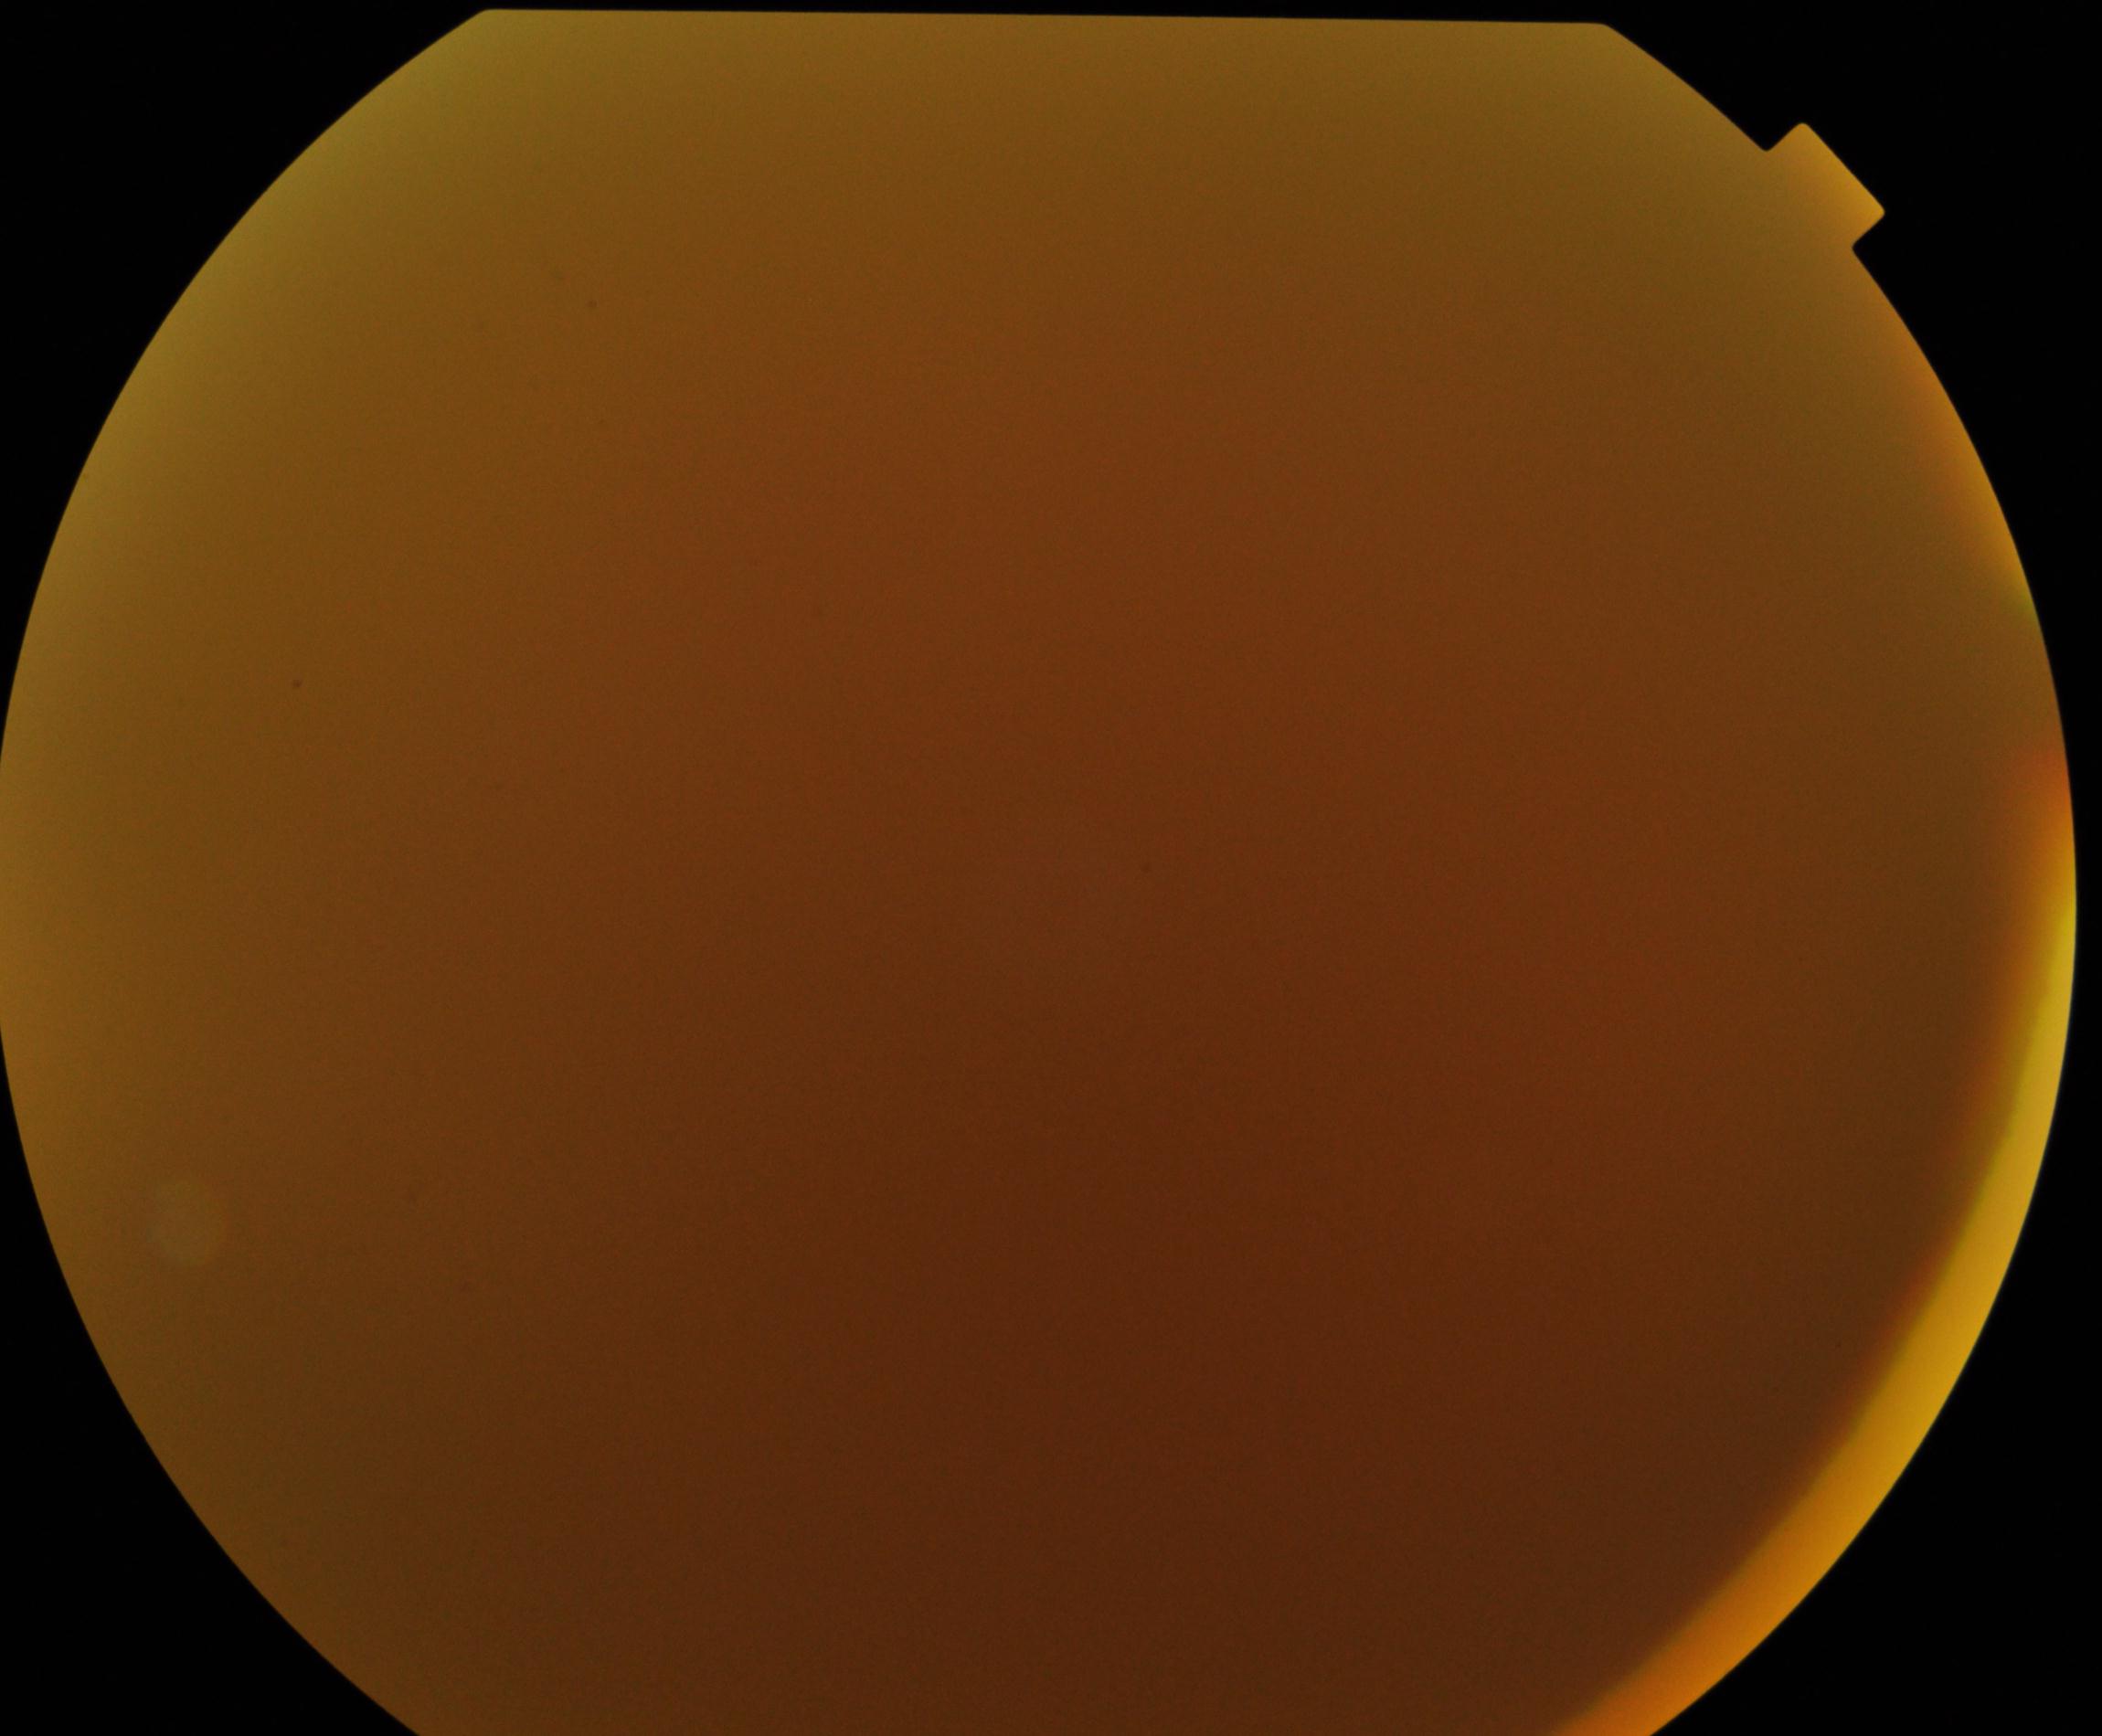 Quality: poor. Proliferative diabetic retinopathy: absent.